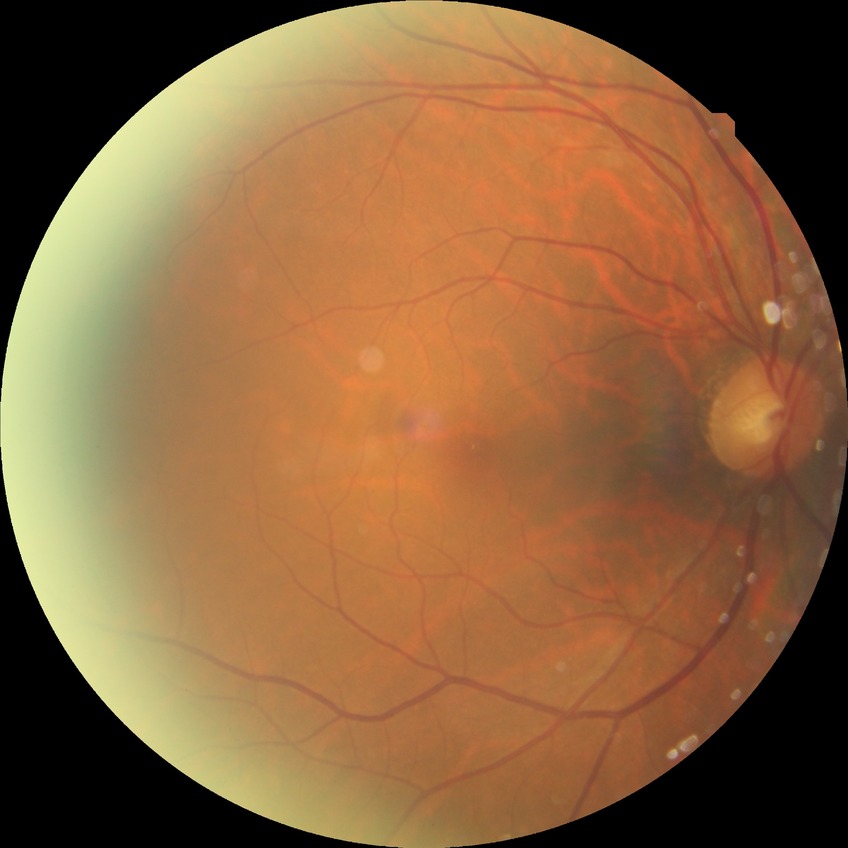 Modified Davis grading is no diabetic retinopathy.